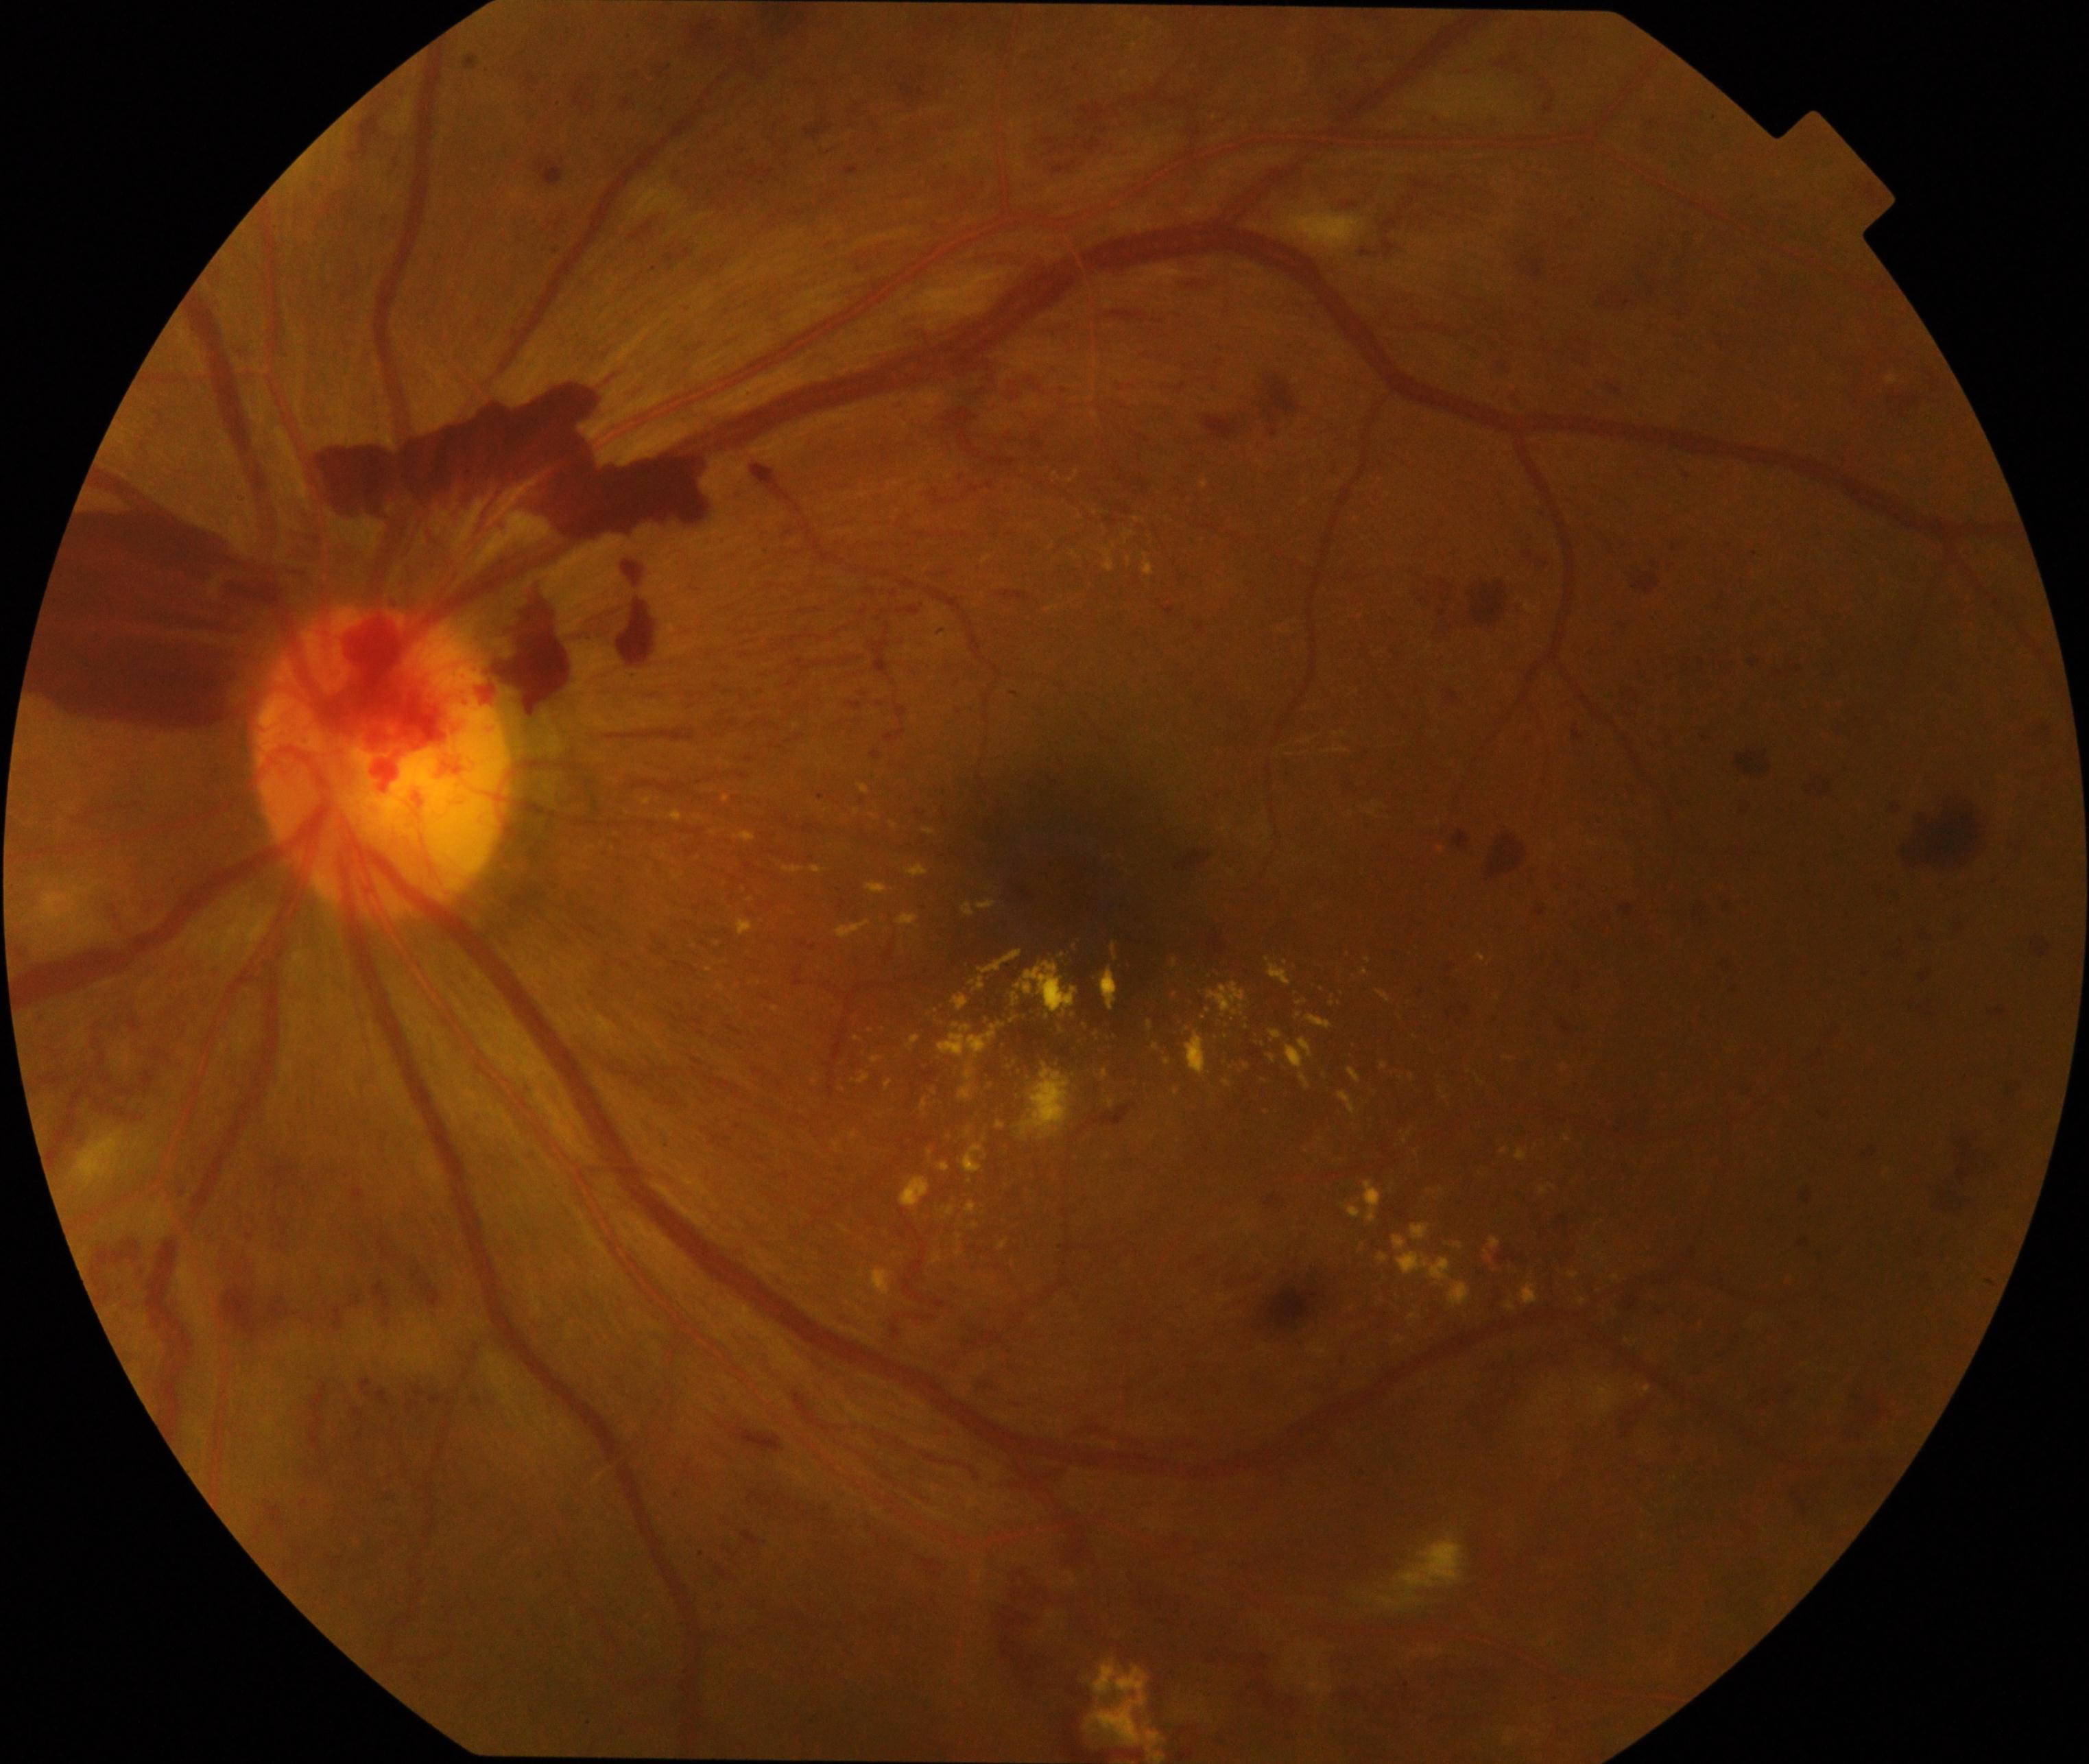 Primary finding: severe non-proliferative or proliferative diabetic retinopathy.